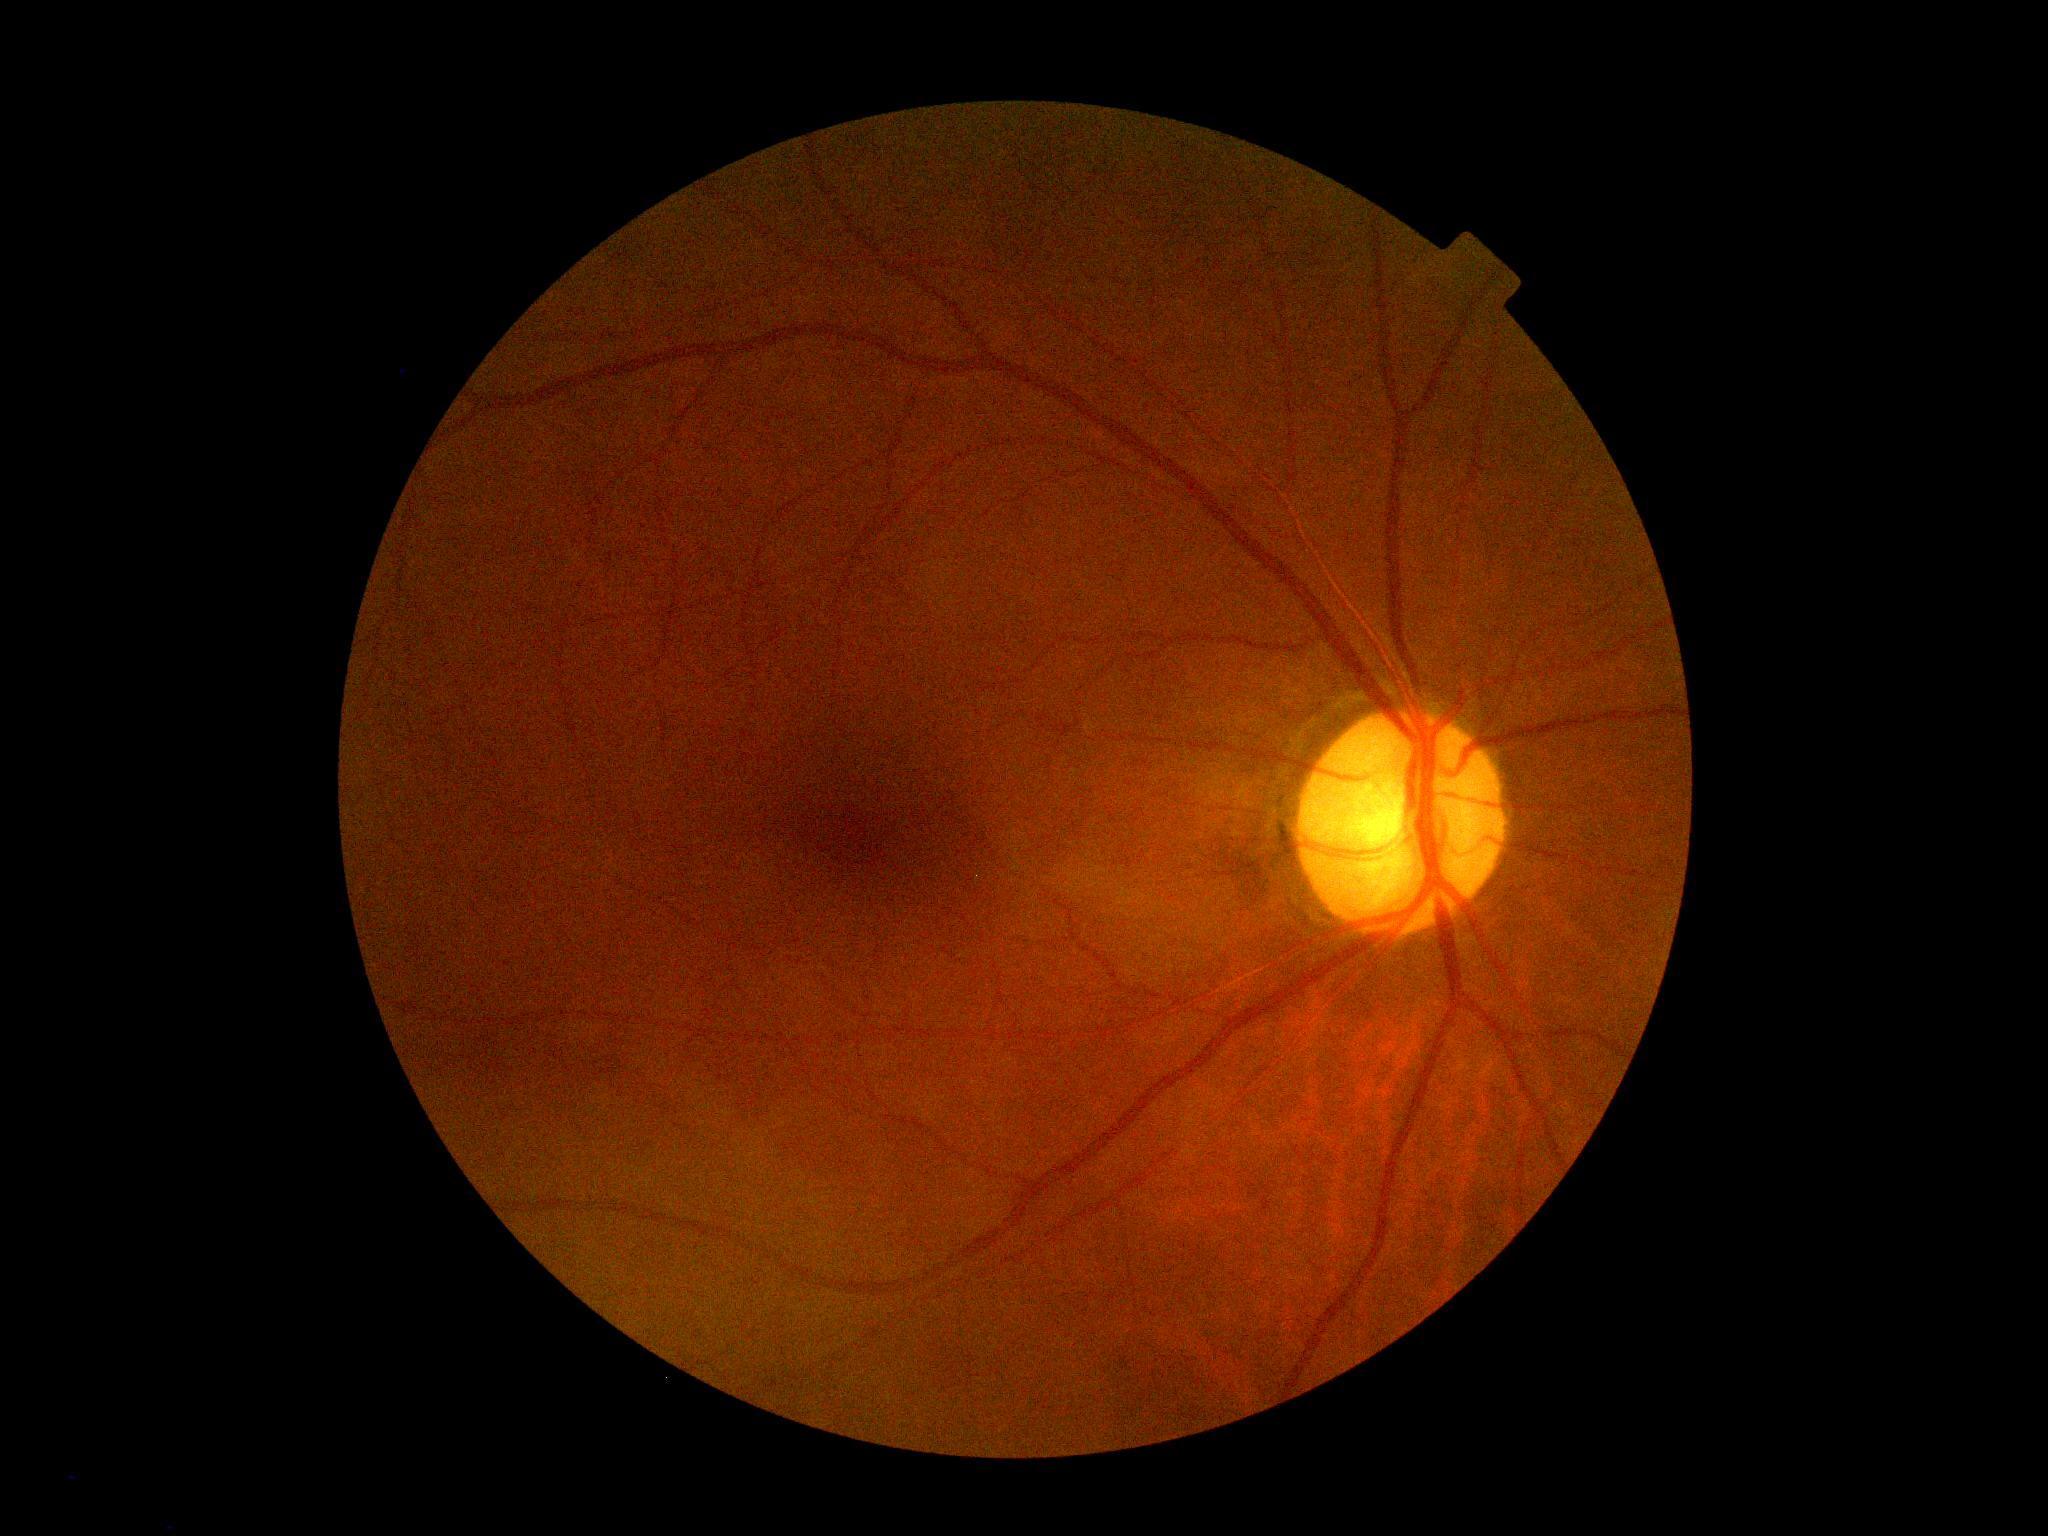
{
  "dr_grade": "grade 0 (no apparent retinopathy)"
}